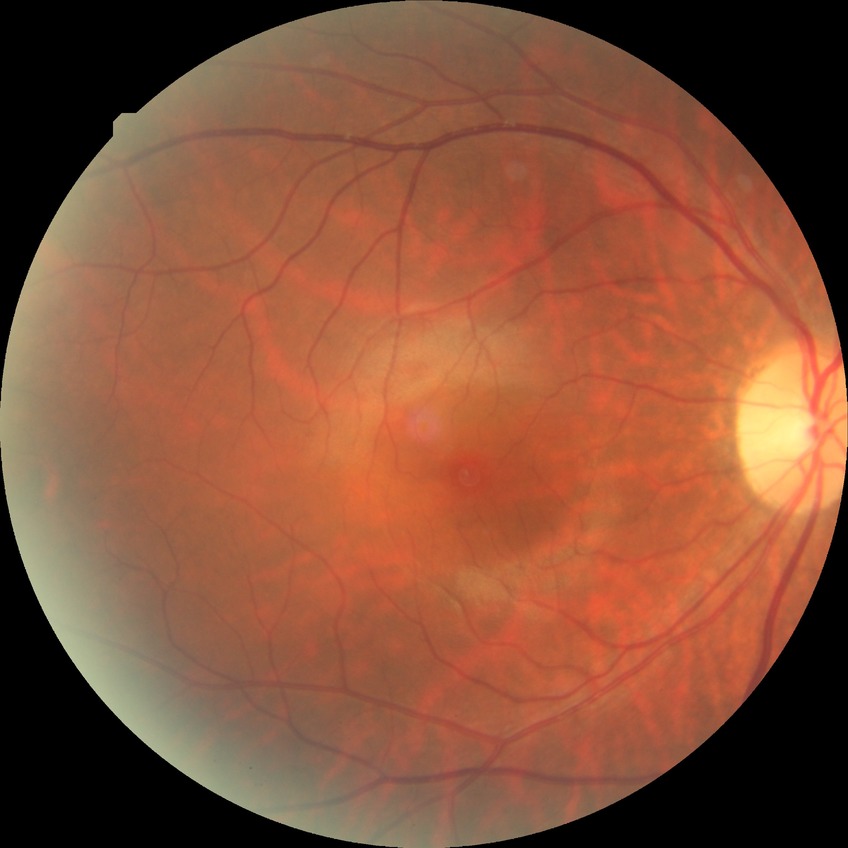

Davis grade: NDR.
No apparent diabetic retinopathy.